Color fundus image · modified Davis grading · 848x848 · 45° field of view: 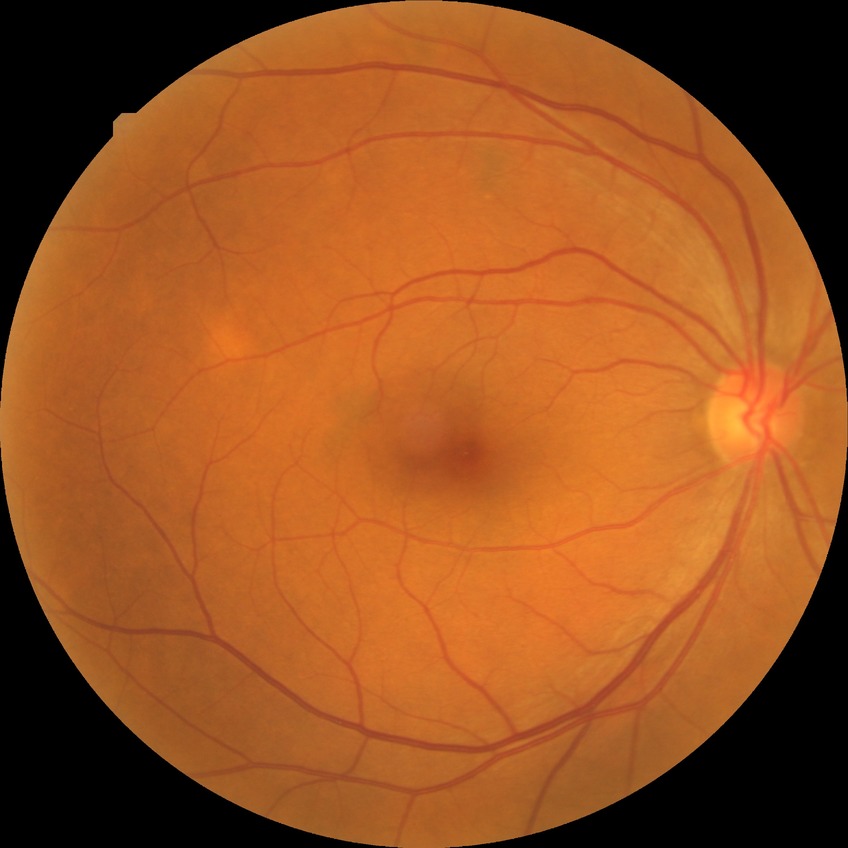
Diabetic retinopathy (DR) is NDR (no diabetic retinopathy).